CFP, mydriatic (tropicamide and phenylephrine).
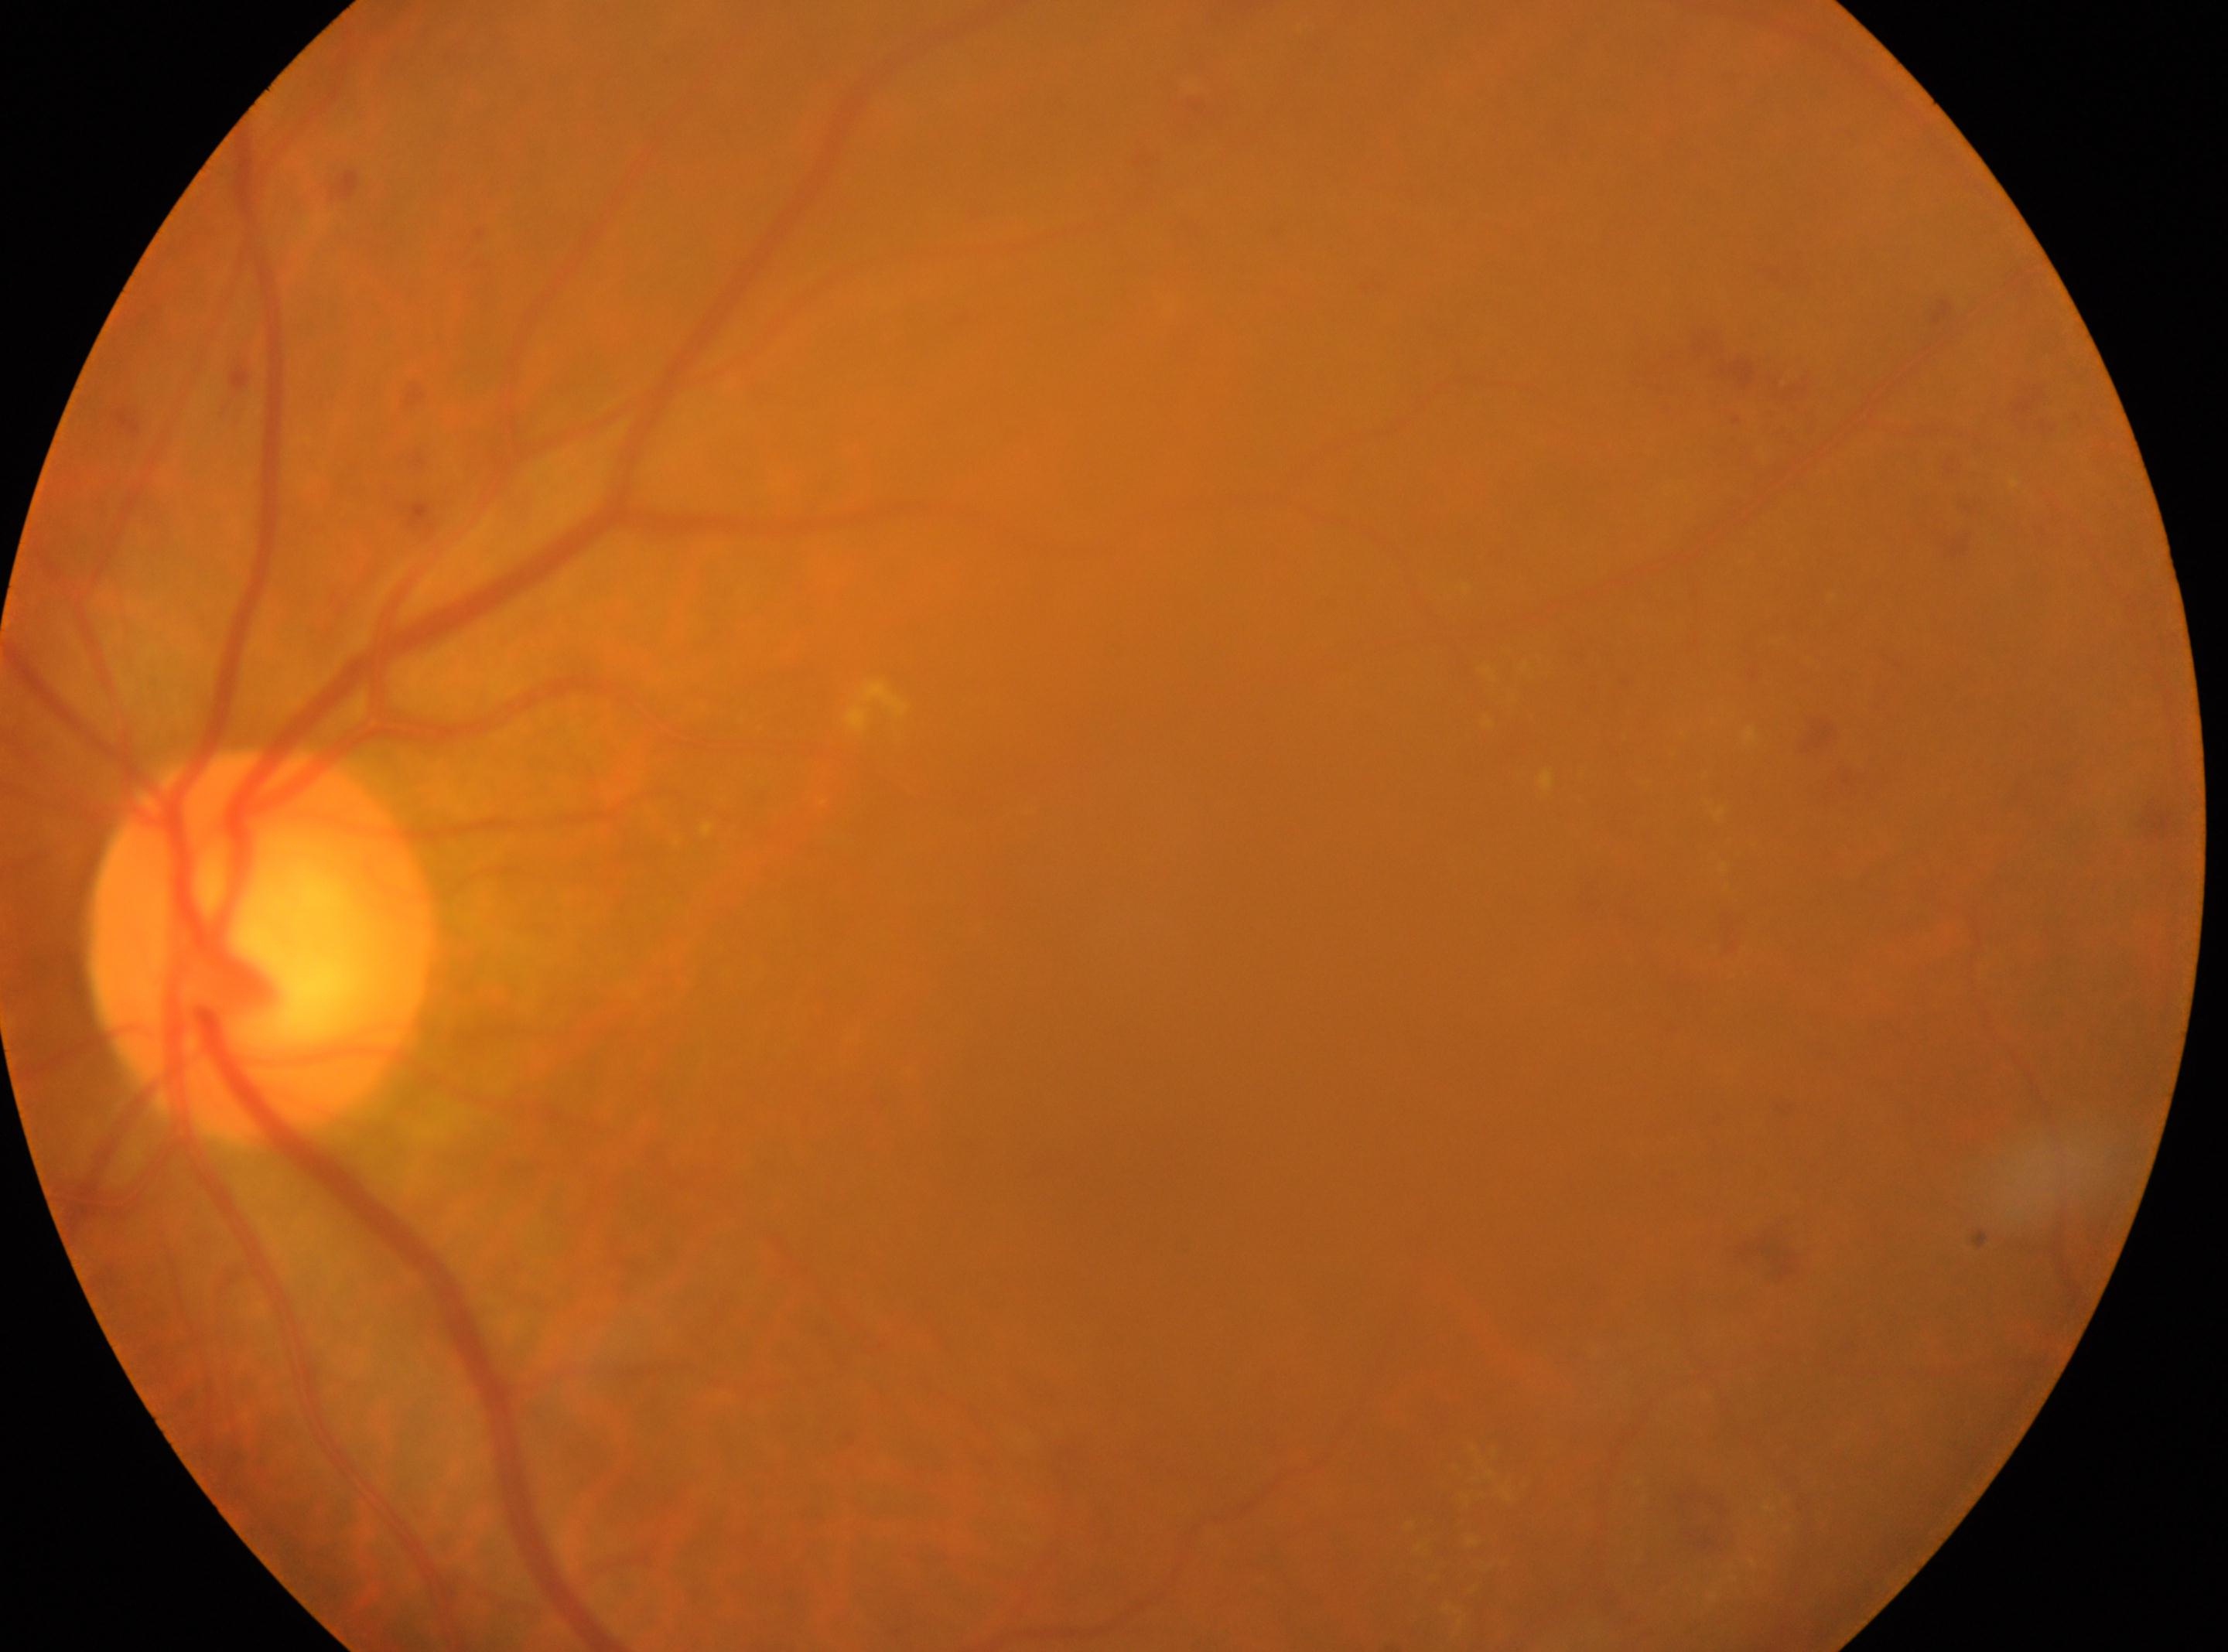
The image shows the left eye. The optic disc center is at [258, 944]. The macula center is at [1154, 1109]. Diabetic retinopathy (DR): grade 2 (moderate NPDR).